Fundus photo · 2352x1568px · FOV: 45 degrees.
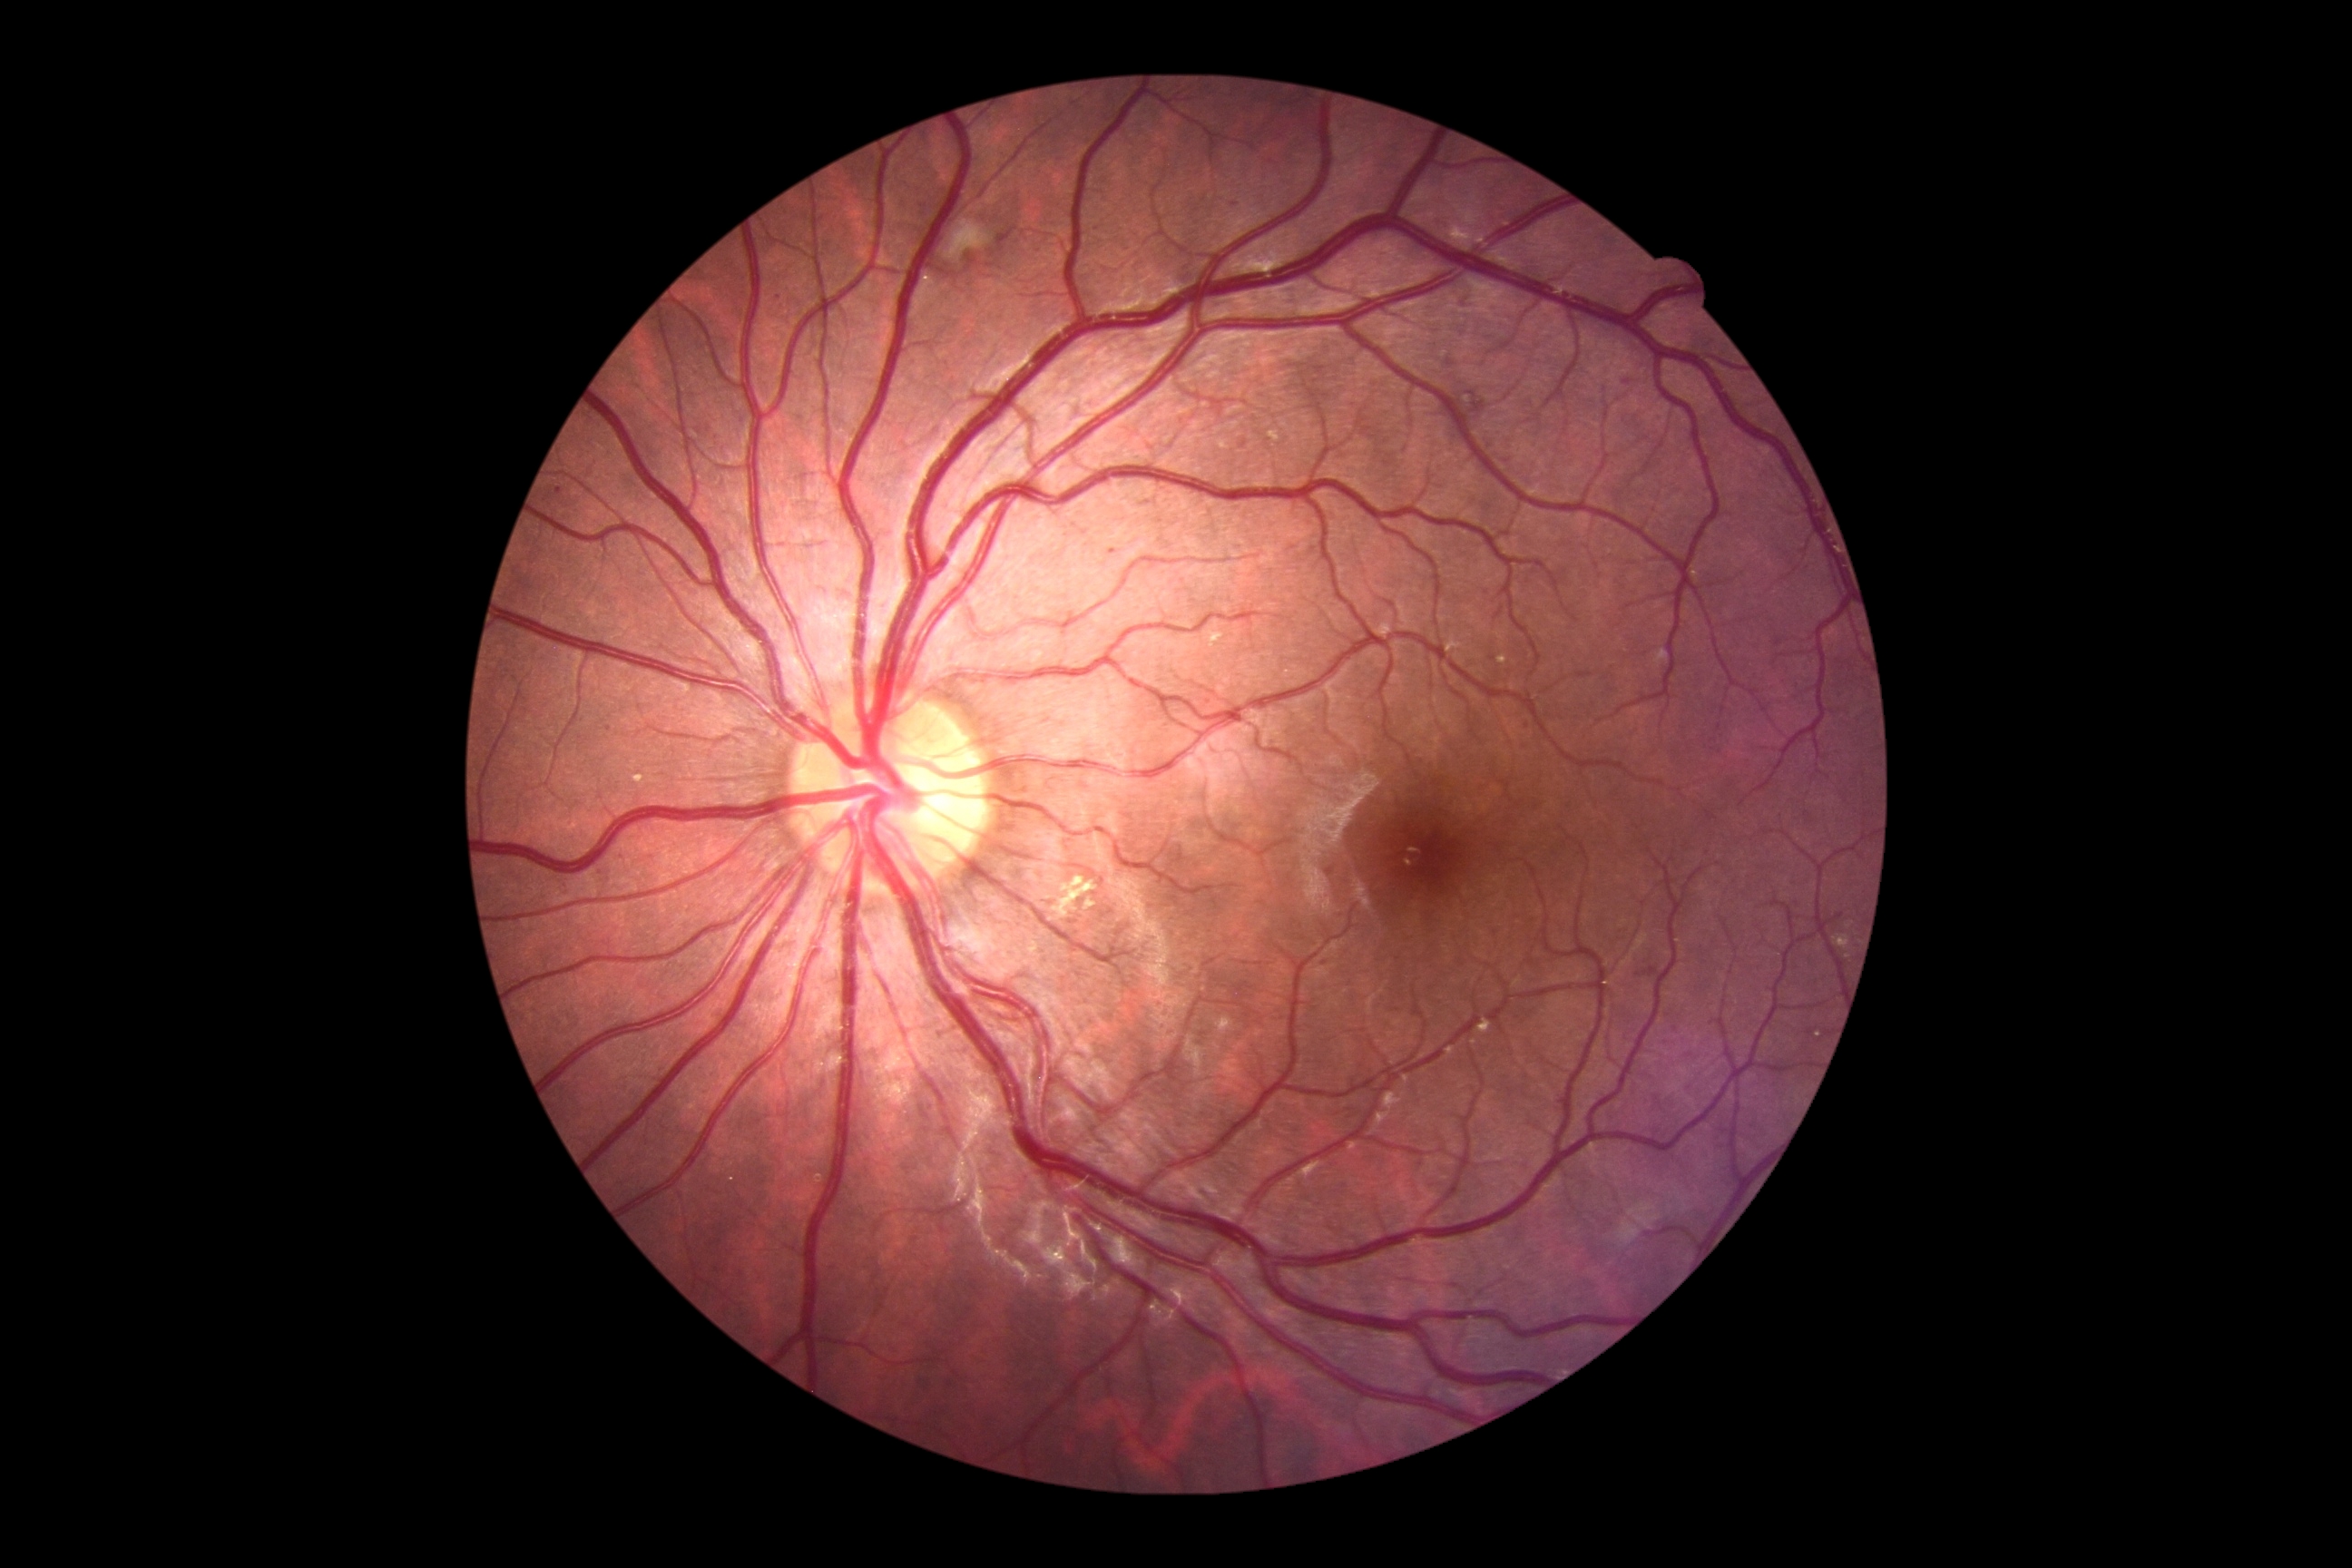 The retinopathy is classified as non-proliferative diabetic retinopathy. DR stage is moderate NPDR (grade 2).